50-degree field of view, retinal fundus photograph, 1924 by 1556 pixels — 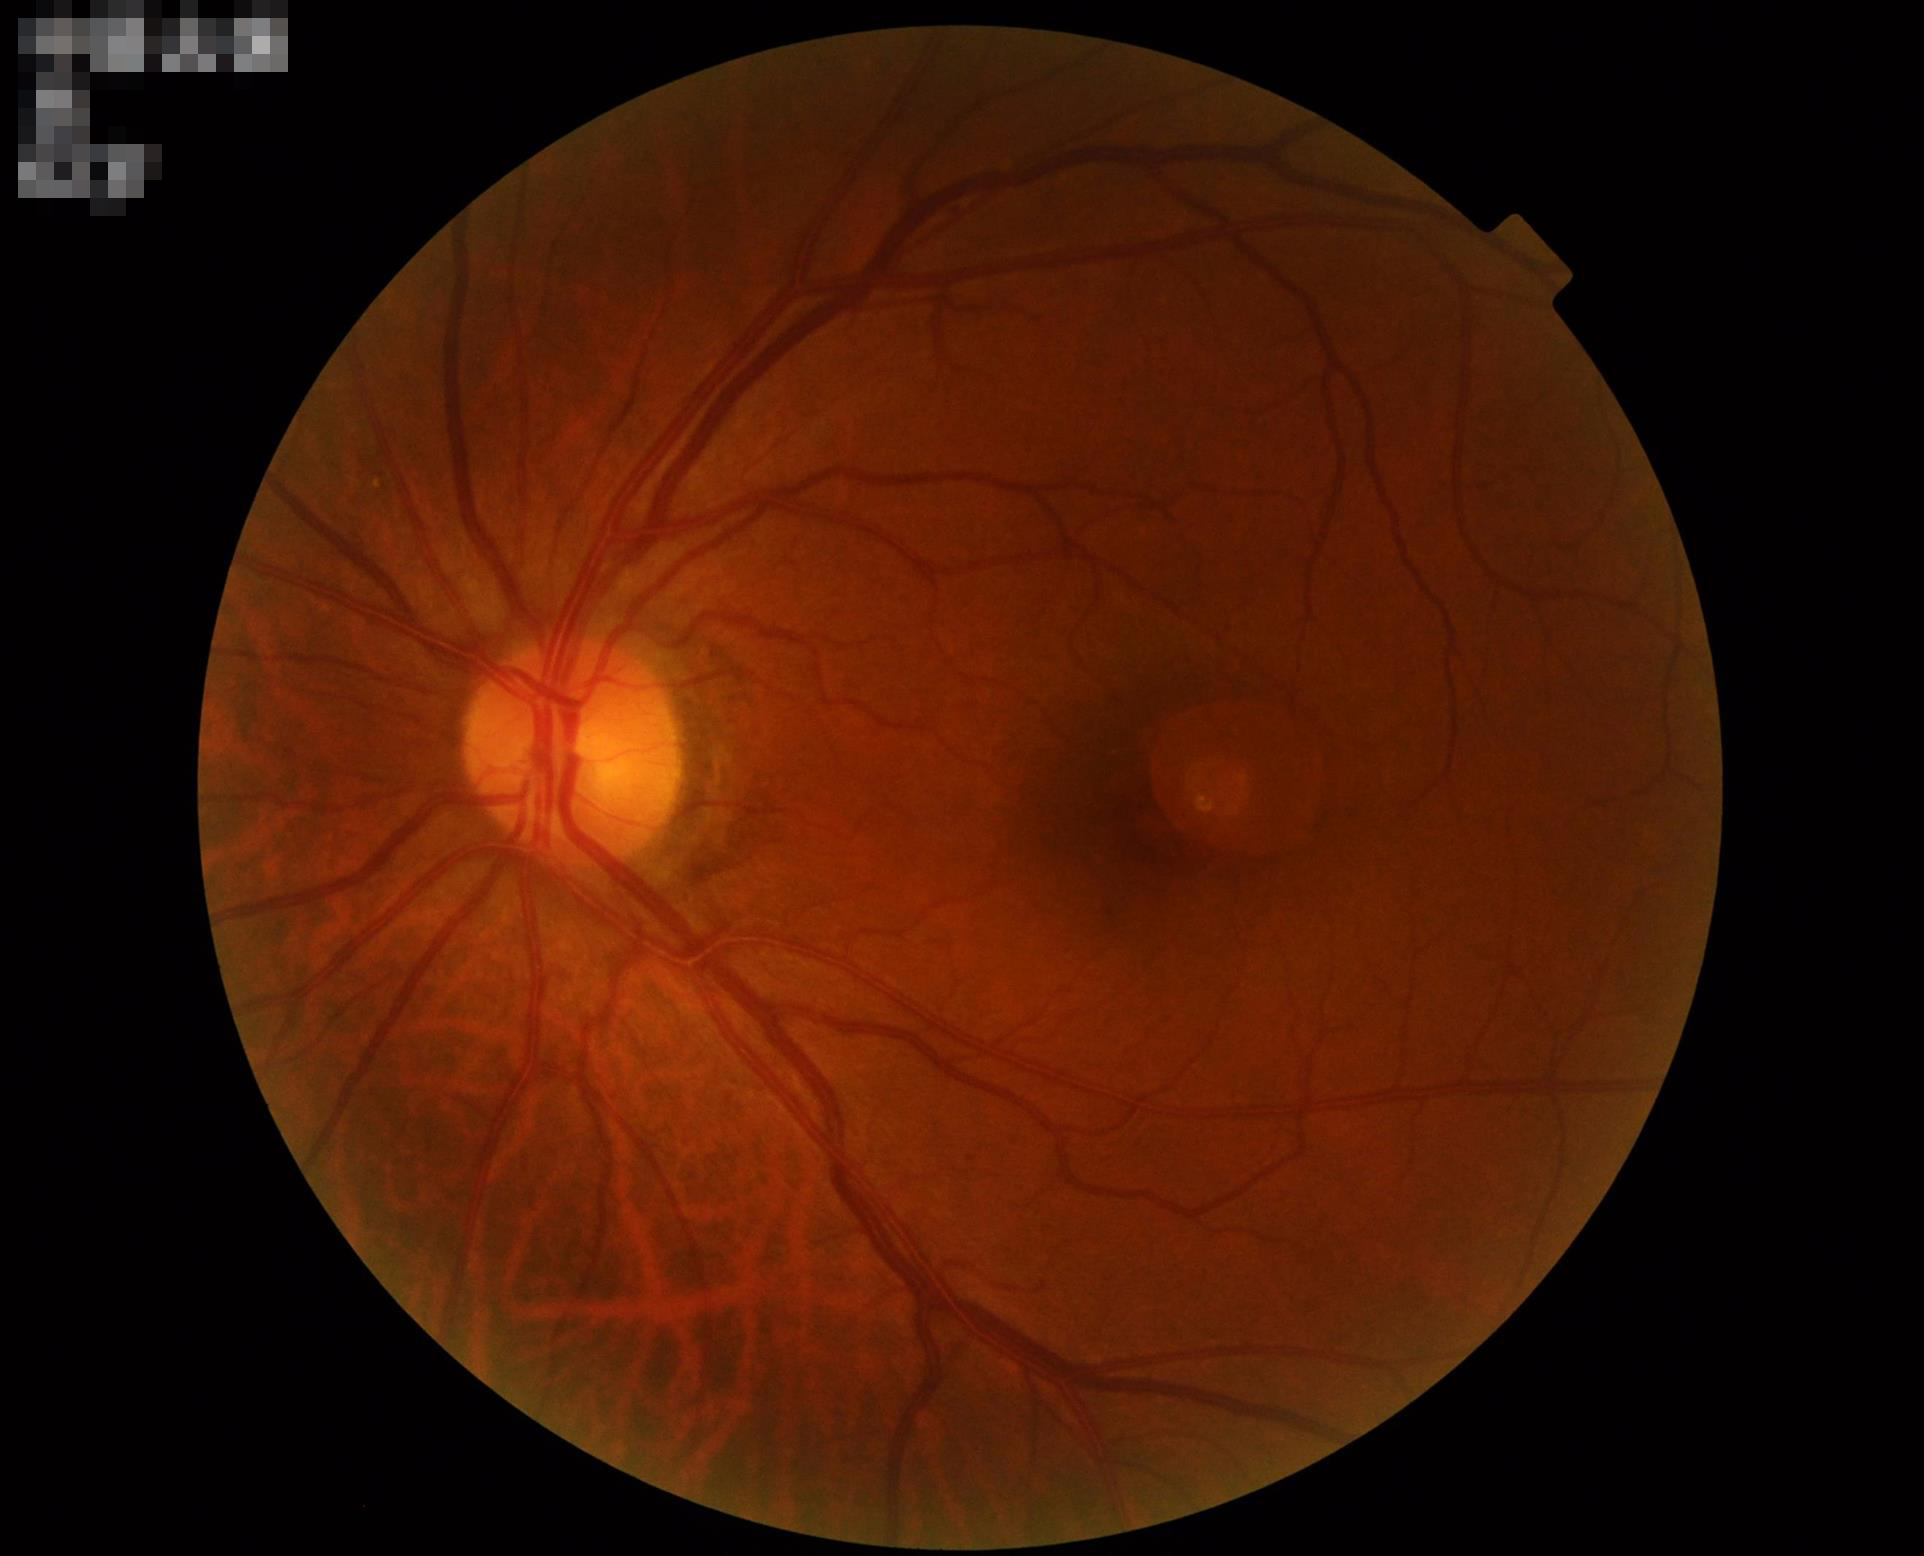

Image is sharp throughout the field.
Overall image quality is good.
Illumination is even.